Graded on the modified Davis scale: 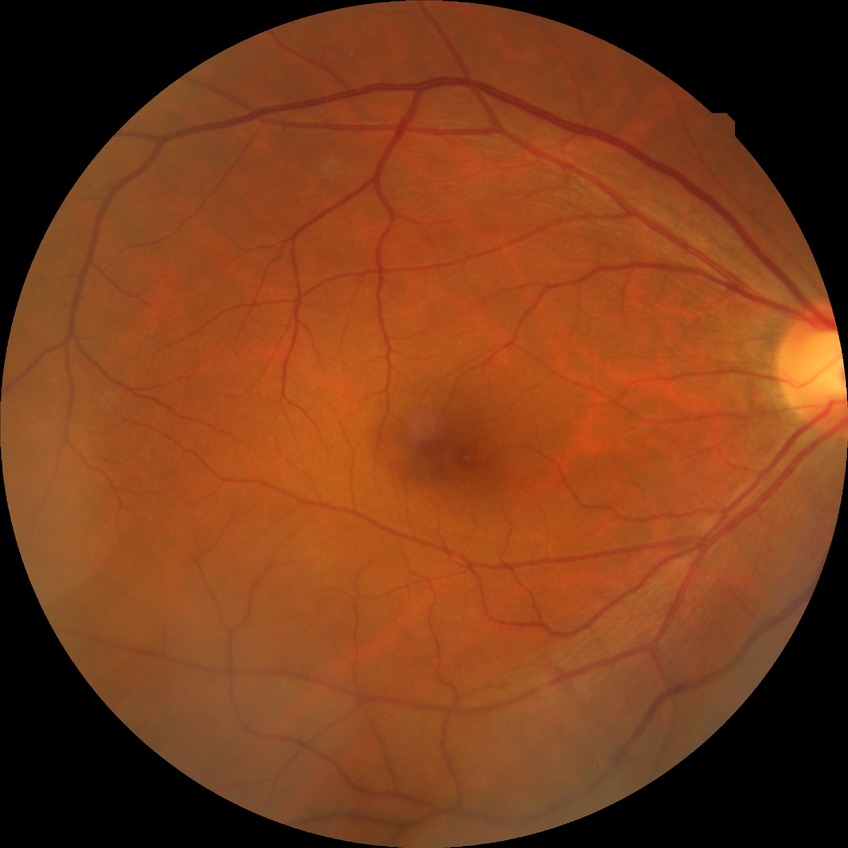
diabetic retinopathy grade: no diabetic retinopathy.